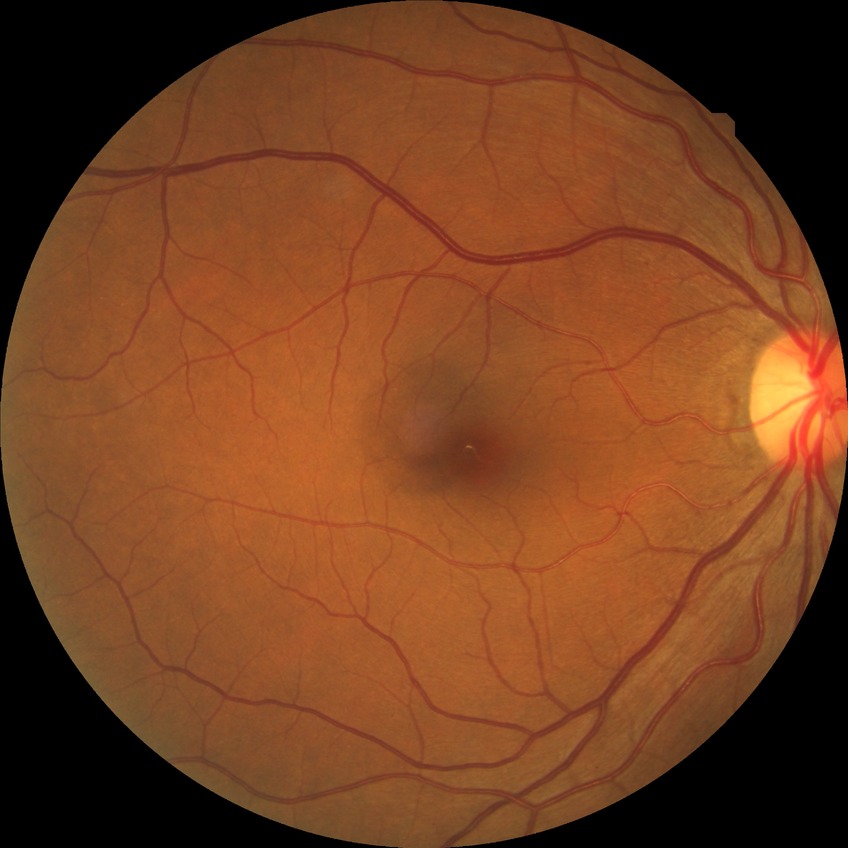
Diabetic retinopathy stage: no diabetic retinopathy.